Optic nerve head photograph: 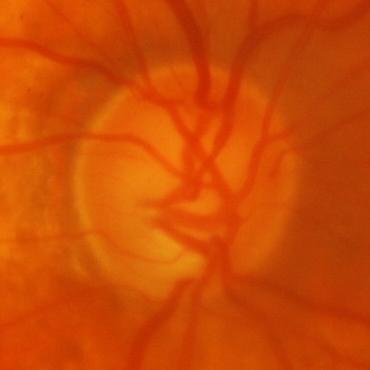

The image shows glaucomatous findings.